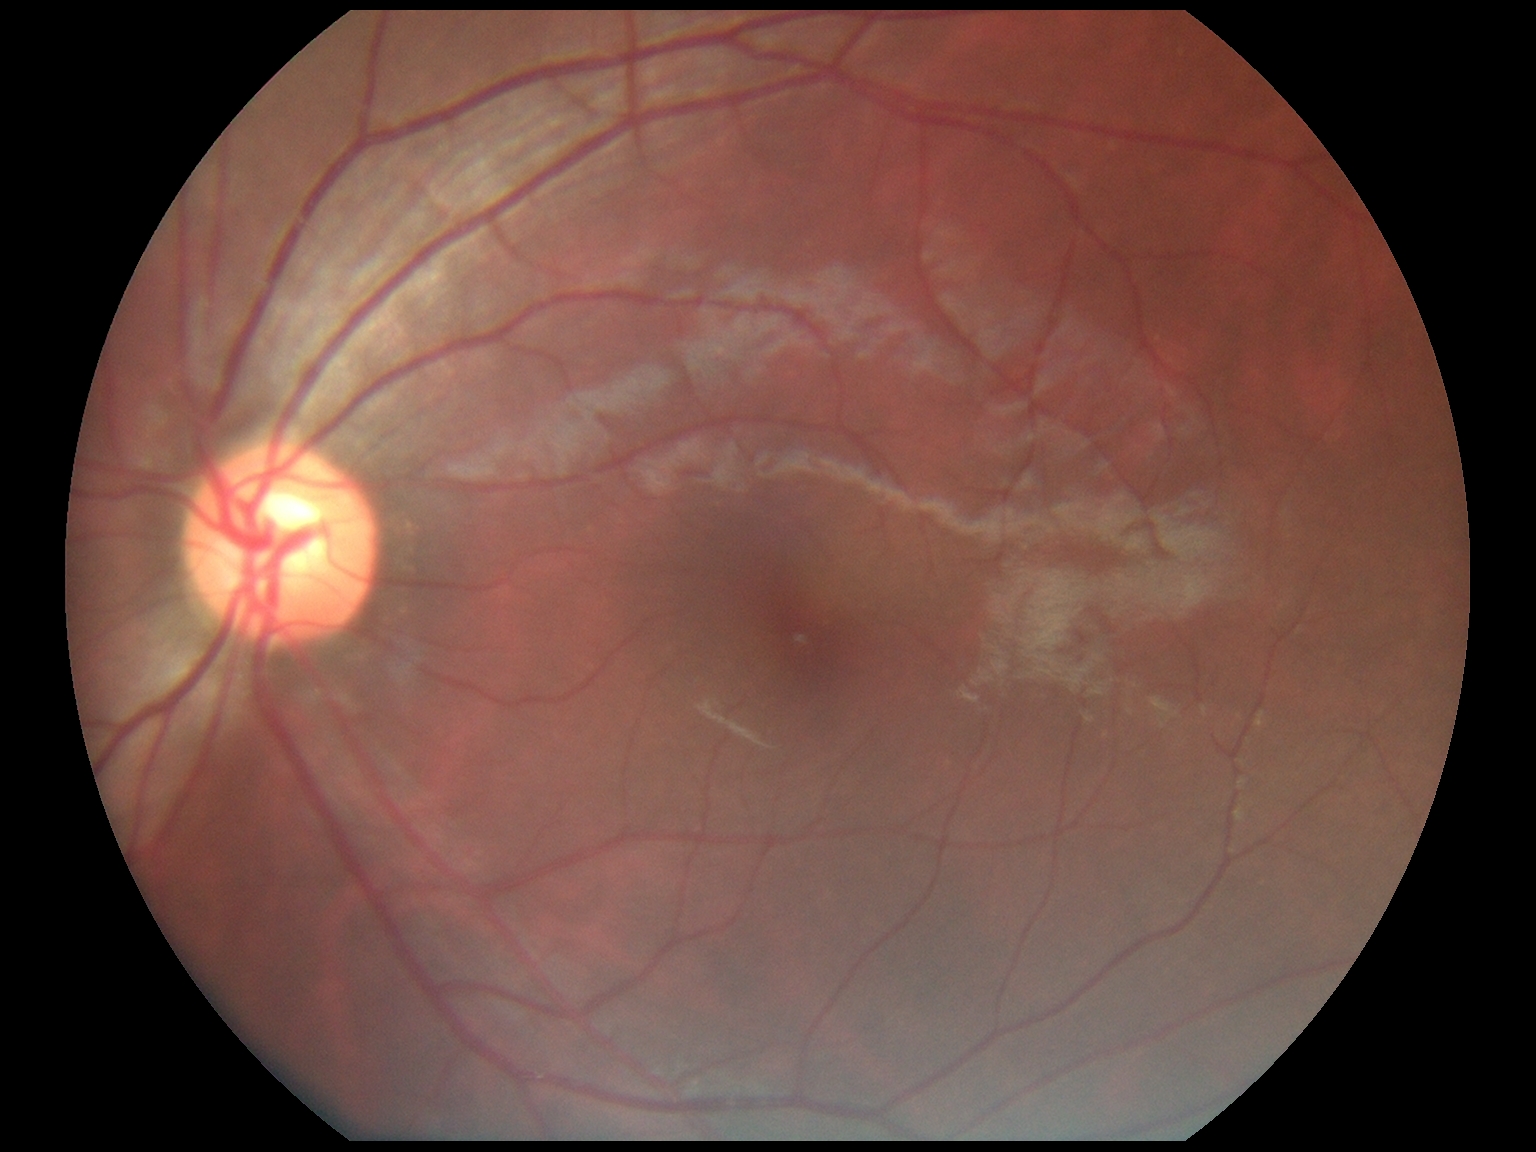

diabetic retinopathy severity=0/4.